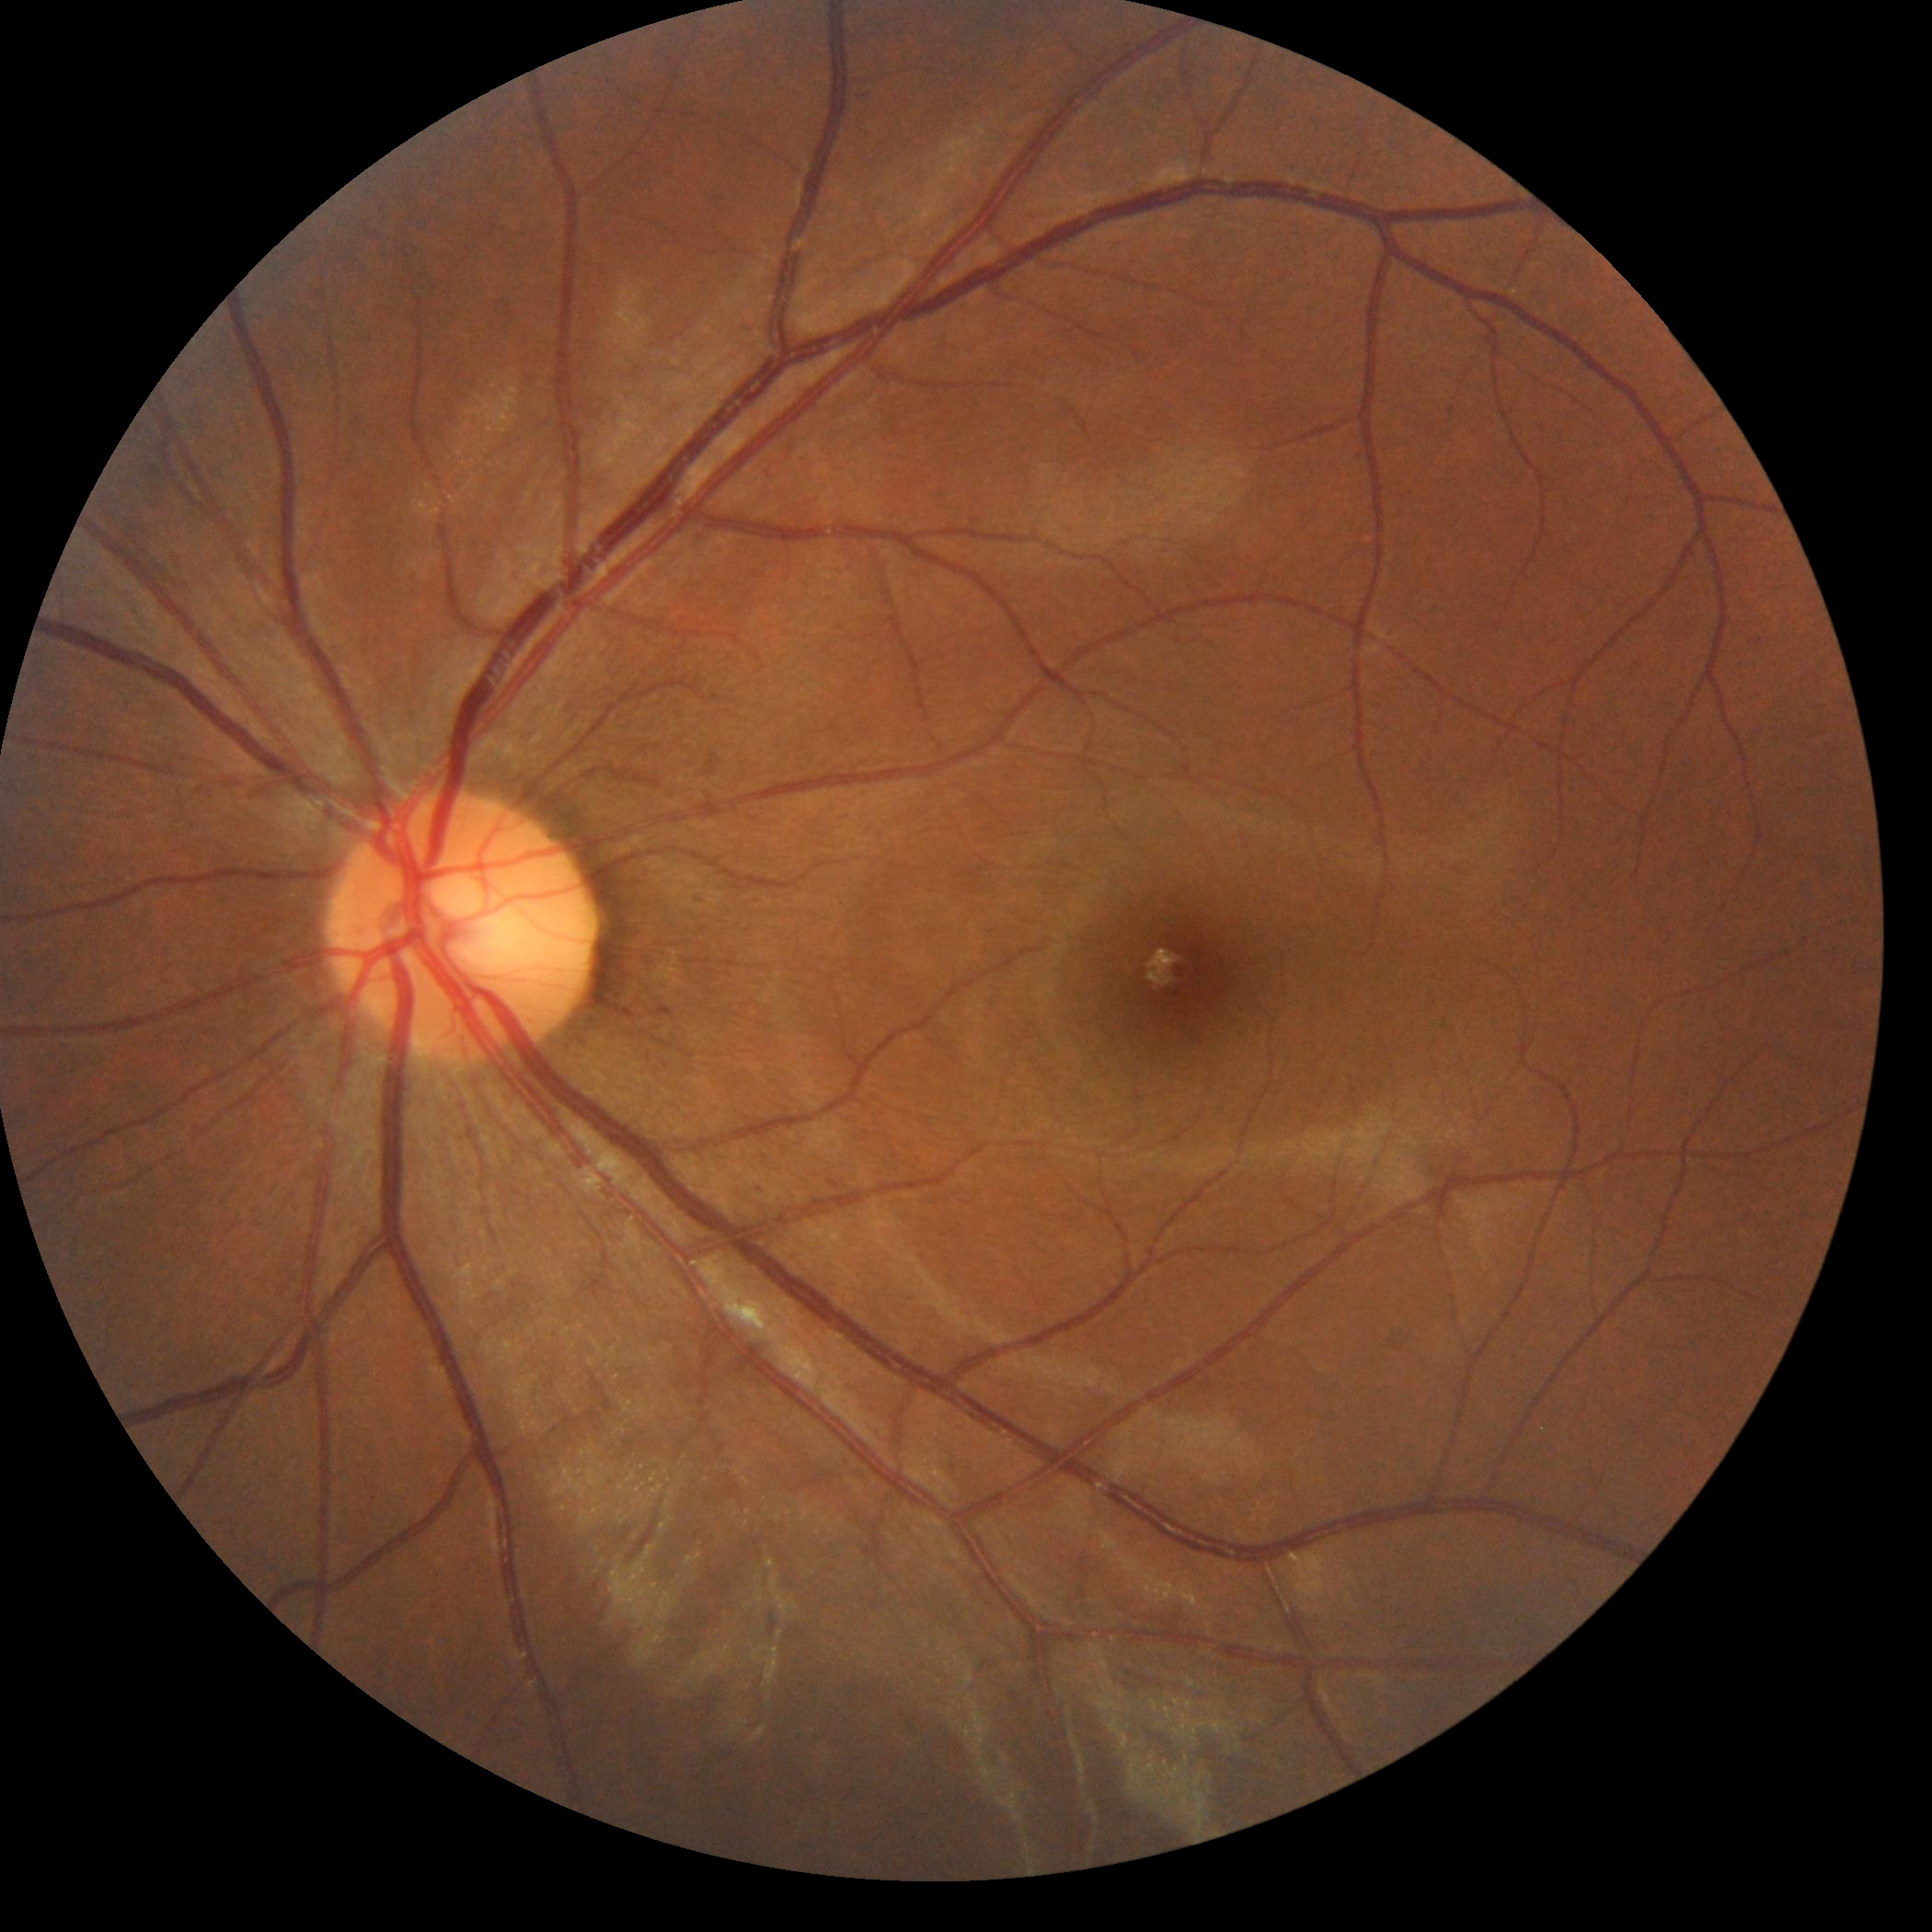
No signs of diabetic retinopathy.
Diabetic retinopathy (DR): 0/4.